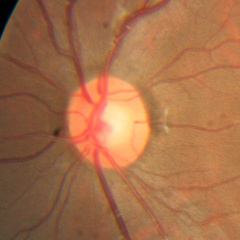
Demonstrates no evidence of glaucoma.